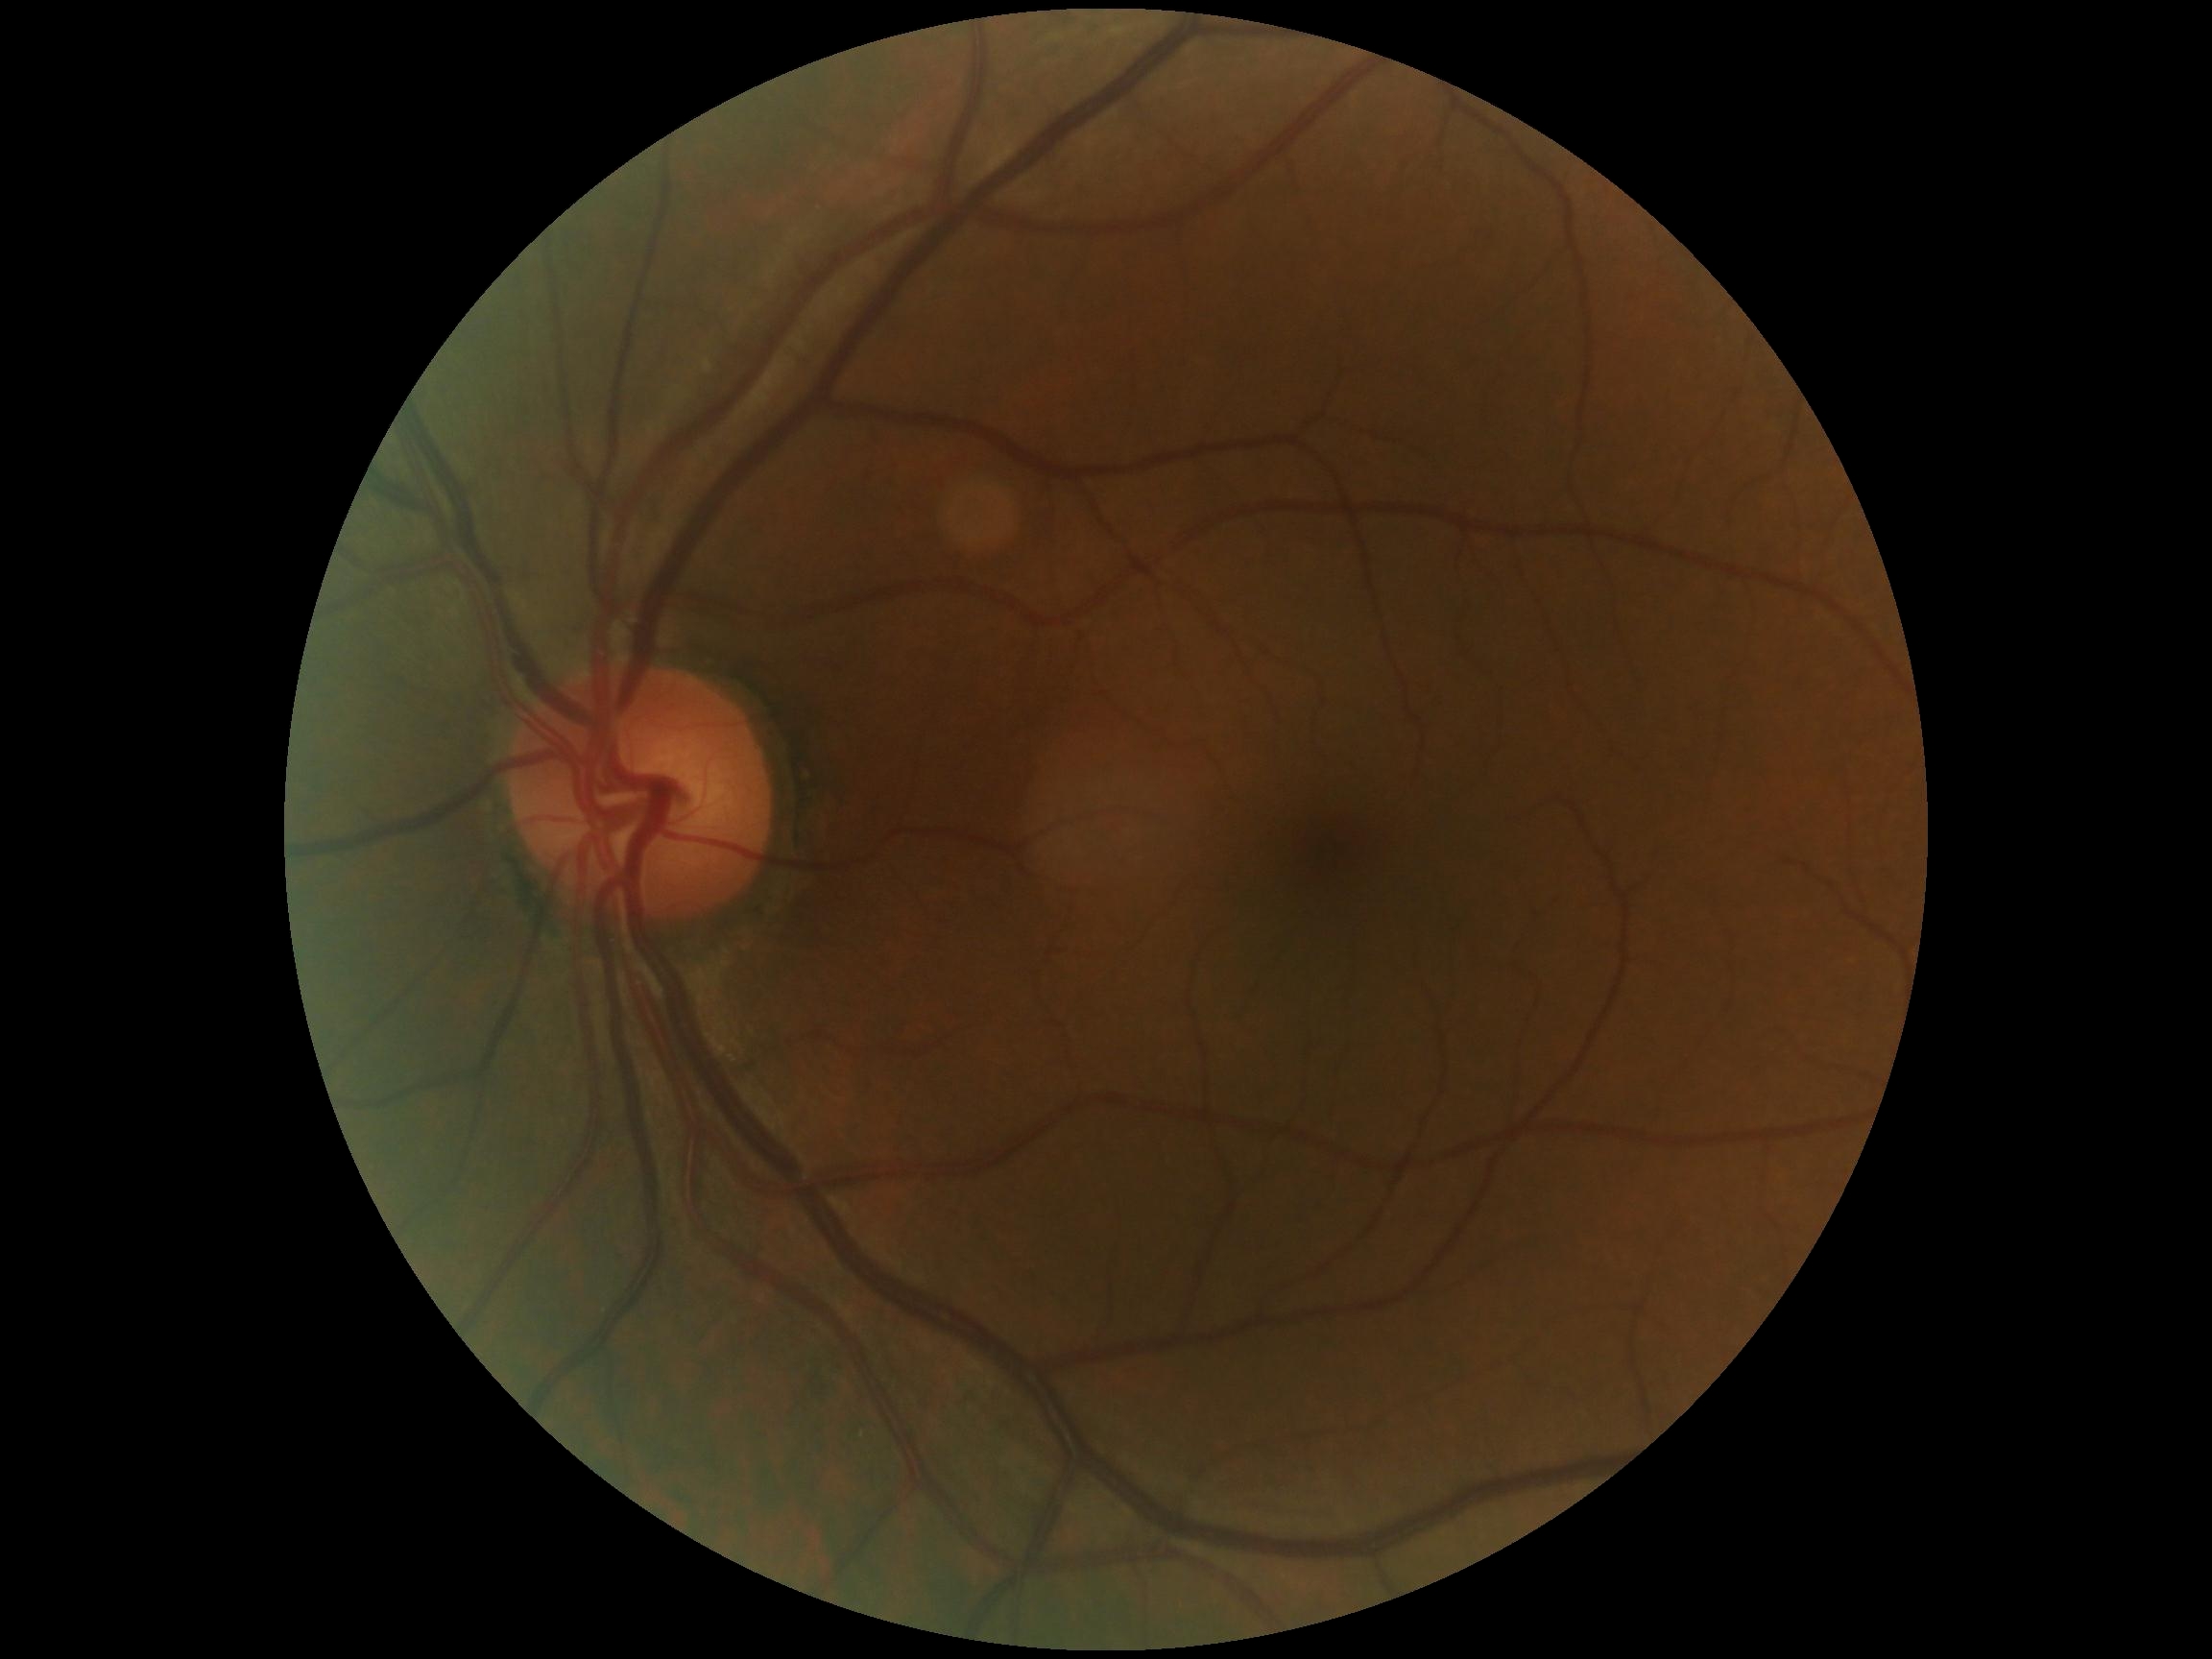

Retinopathy: grade 0 (no apparent retinopathy).